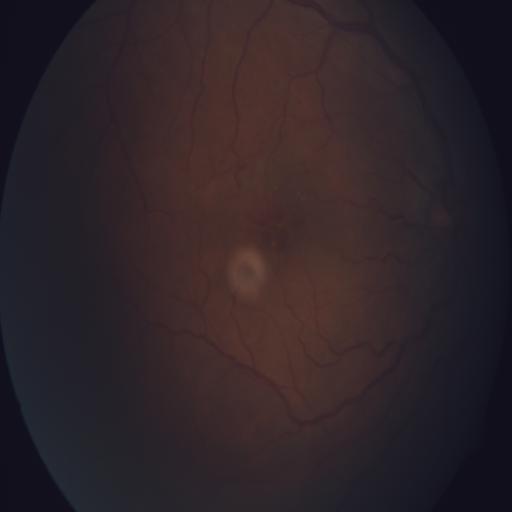

Diagnoses:
- HR (hemorrhagic retinopathy)